Ultra-widefield (UWF) fundus image · 1924 x 1556 pixels.
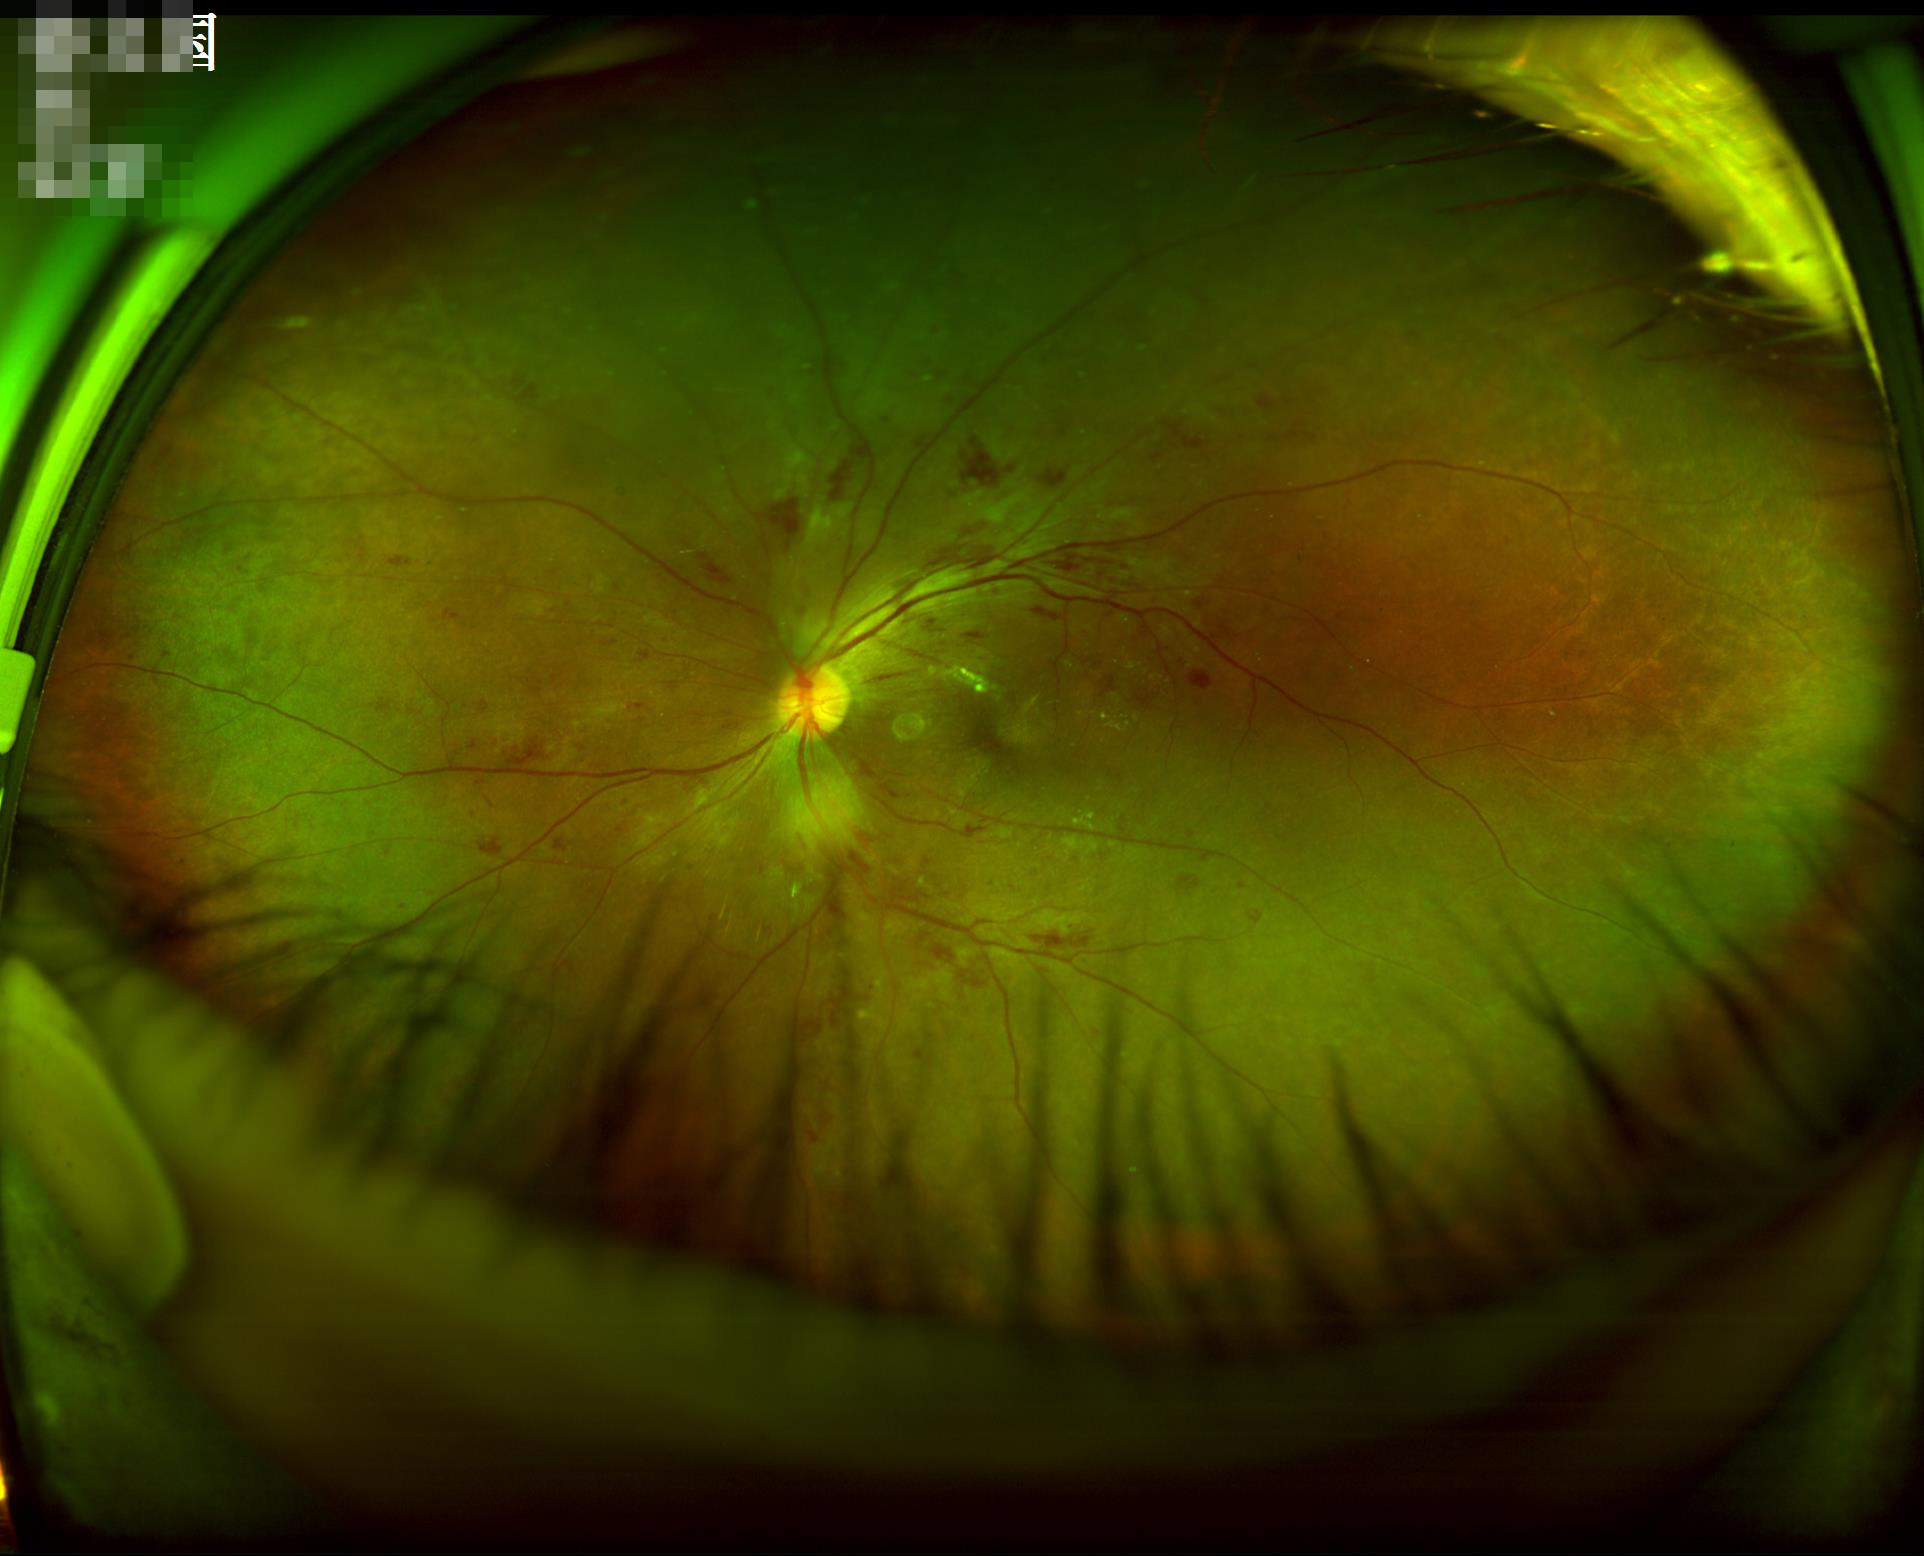
Good dynamic range.
No noticeable blur.
Even illumination with no color cast.